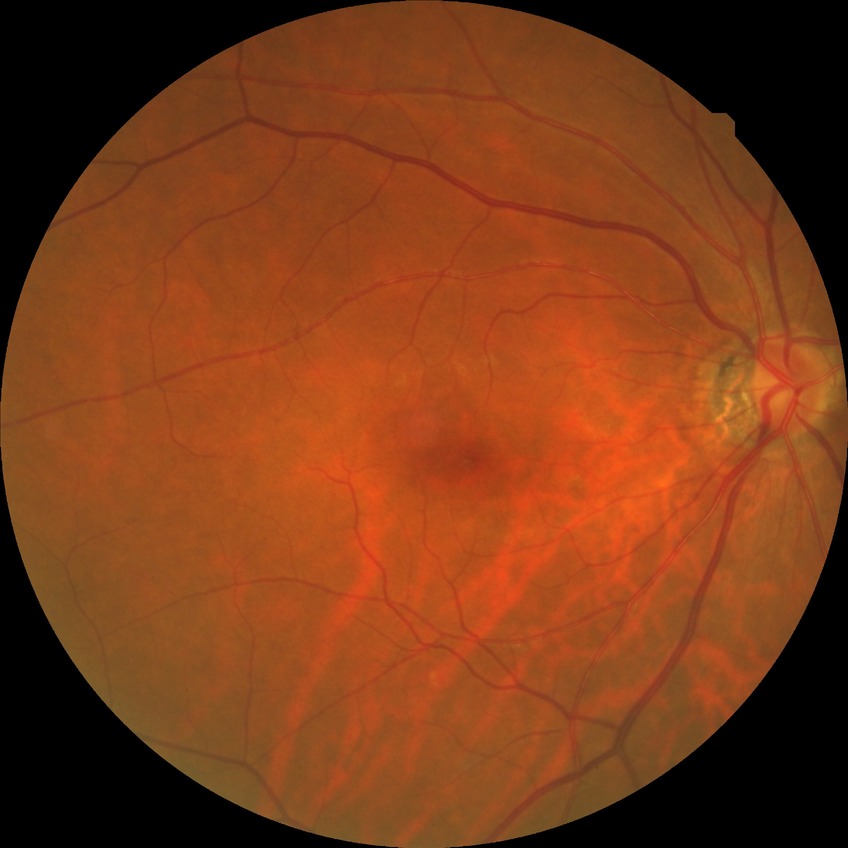 {
  "dr_impression": "no signs of DR",
  "davis_grade": "NDR"
}